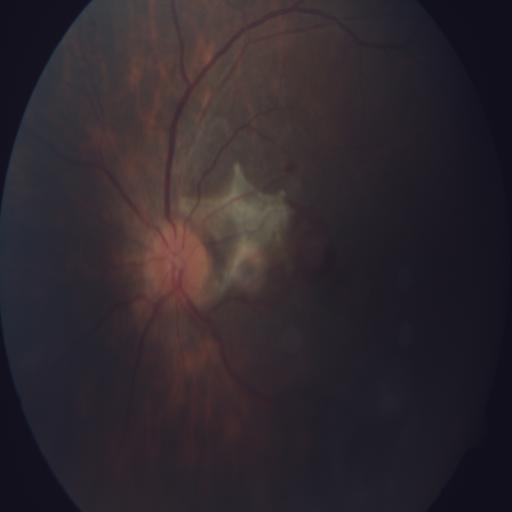

Fundus image with findings of ODE (optic disc edema) and BRVO (branch retinal vein occlusion).